1240x1240px · wide-field fundus photograph of an infant:
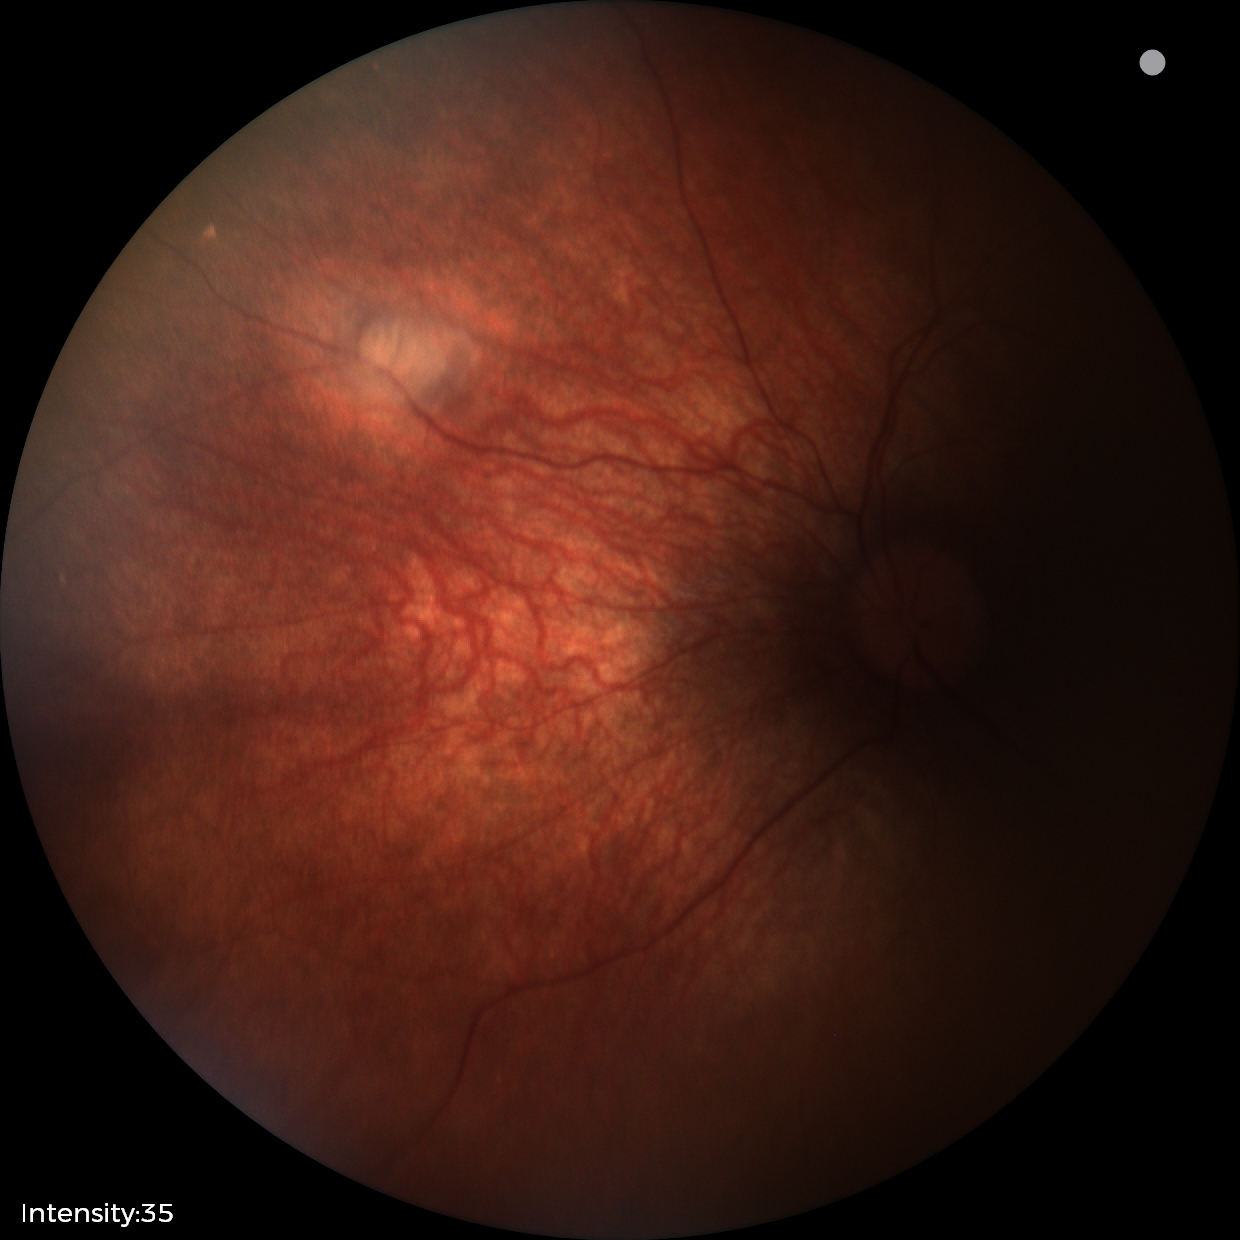
From an examination with diagnosis of retinal astrocytic hamartoma.